Wide-field contact fundus photograph of an infant. 640x480. Camera: Clarity RetCam 3 (130° FOV)
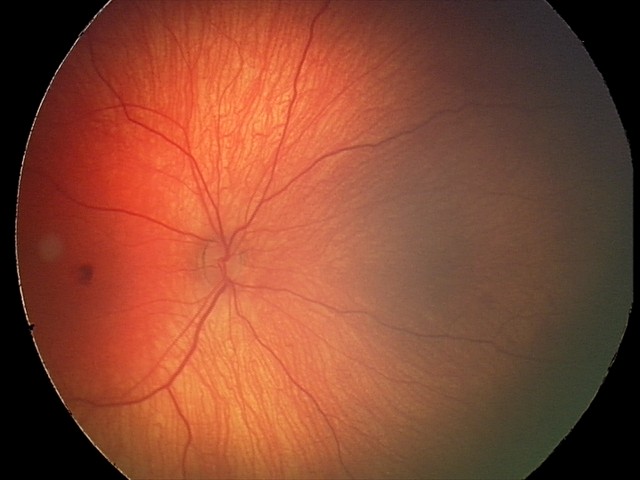 Screening series with retinal hemorrhages.